Captured without pupil dilation
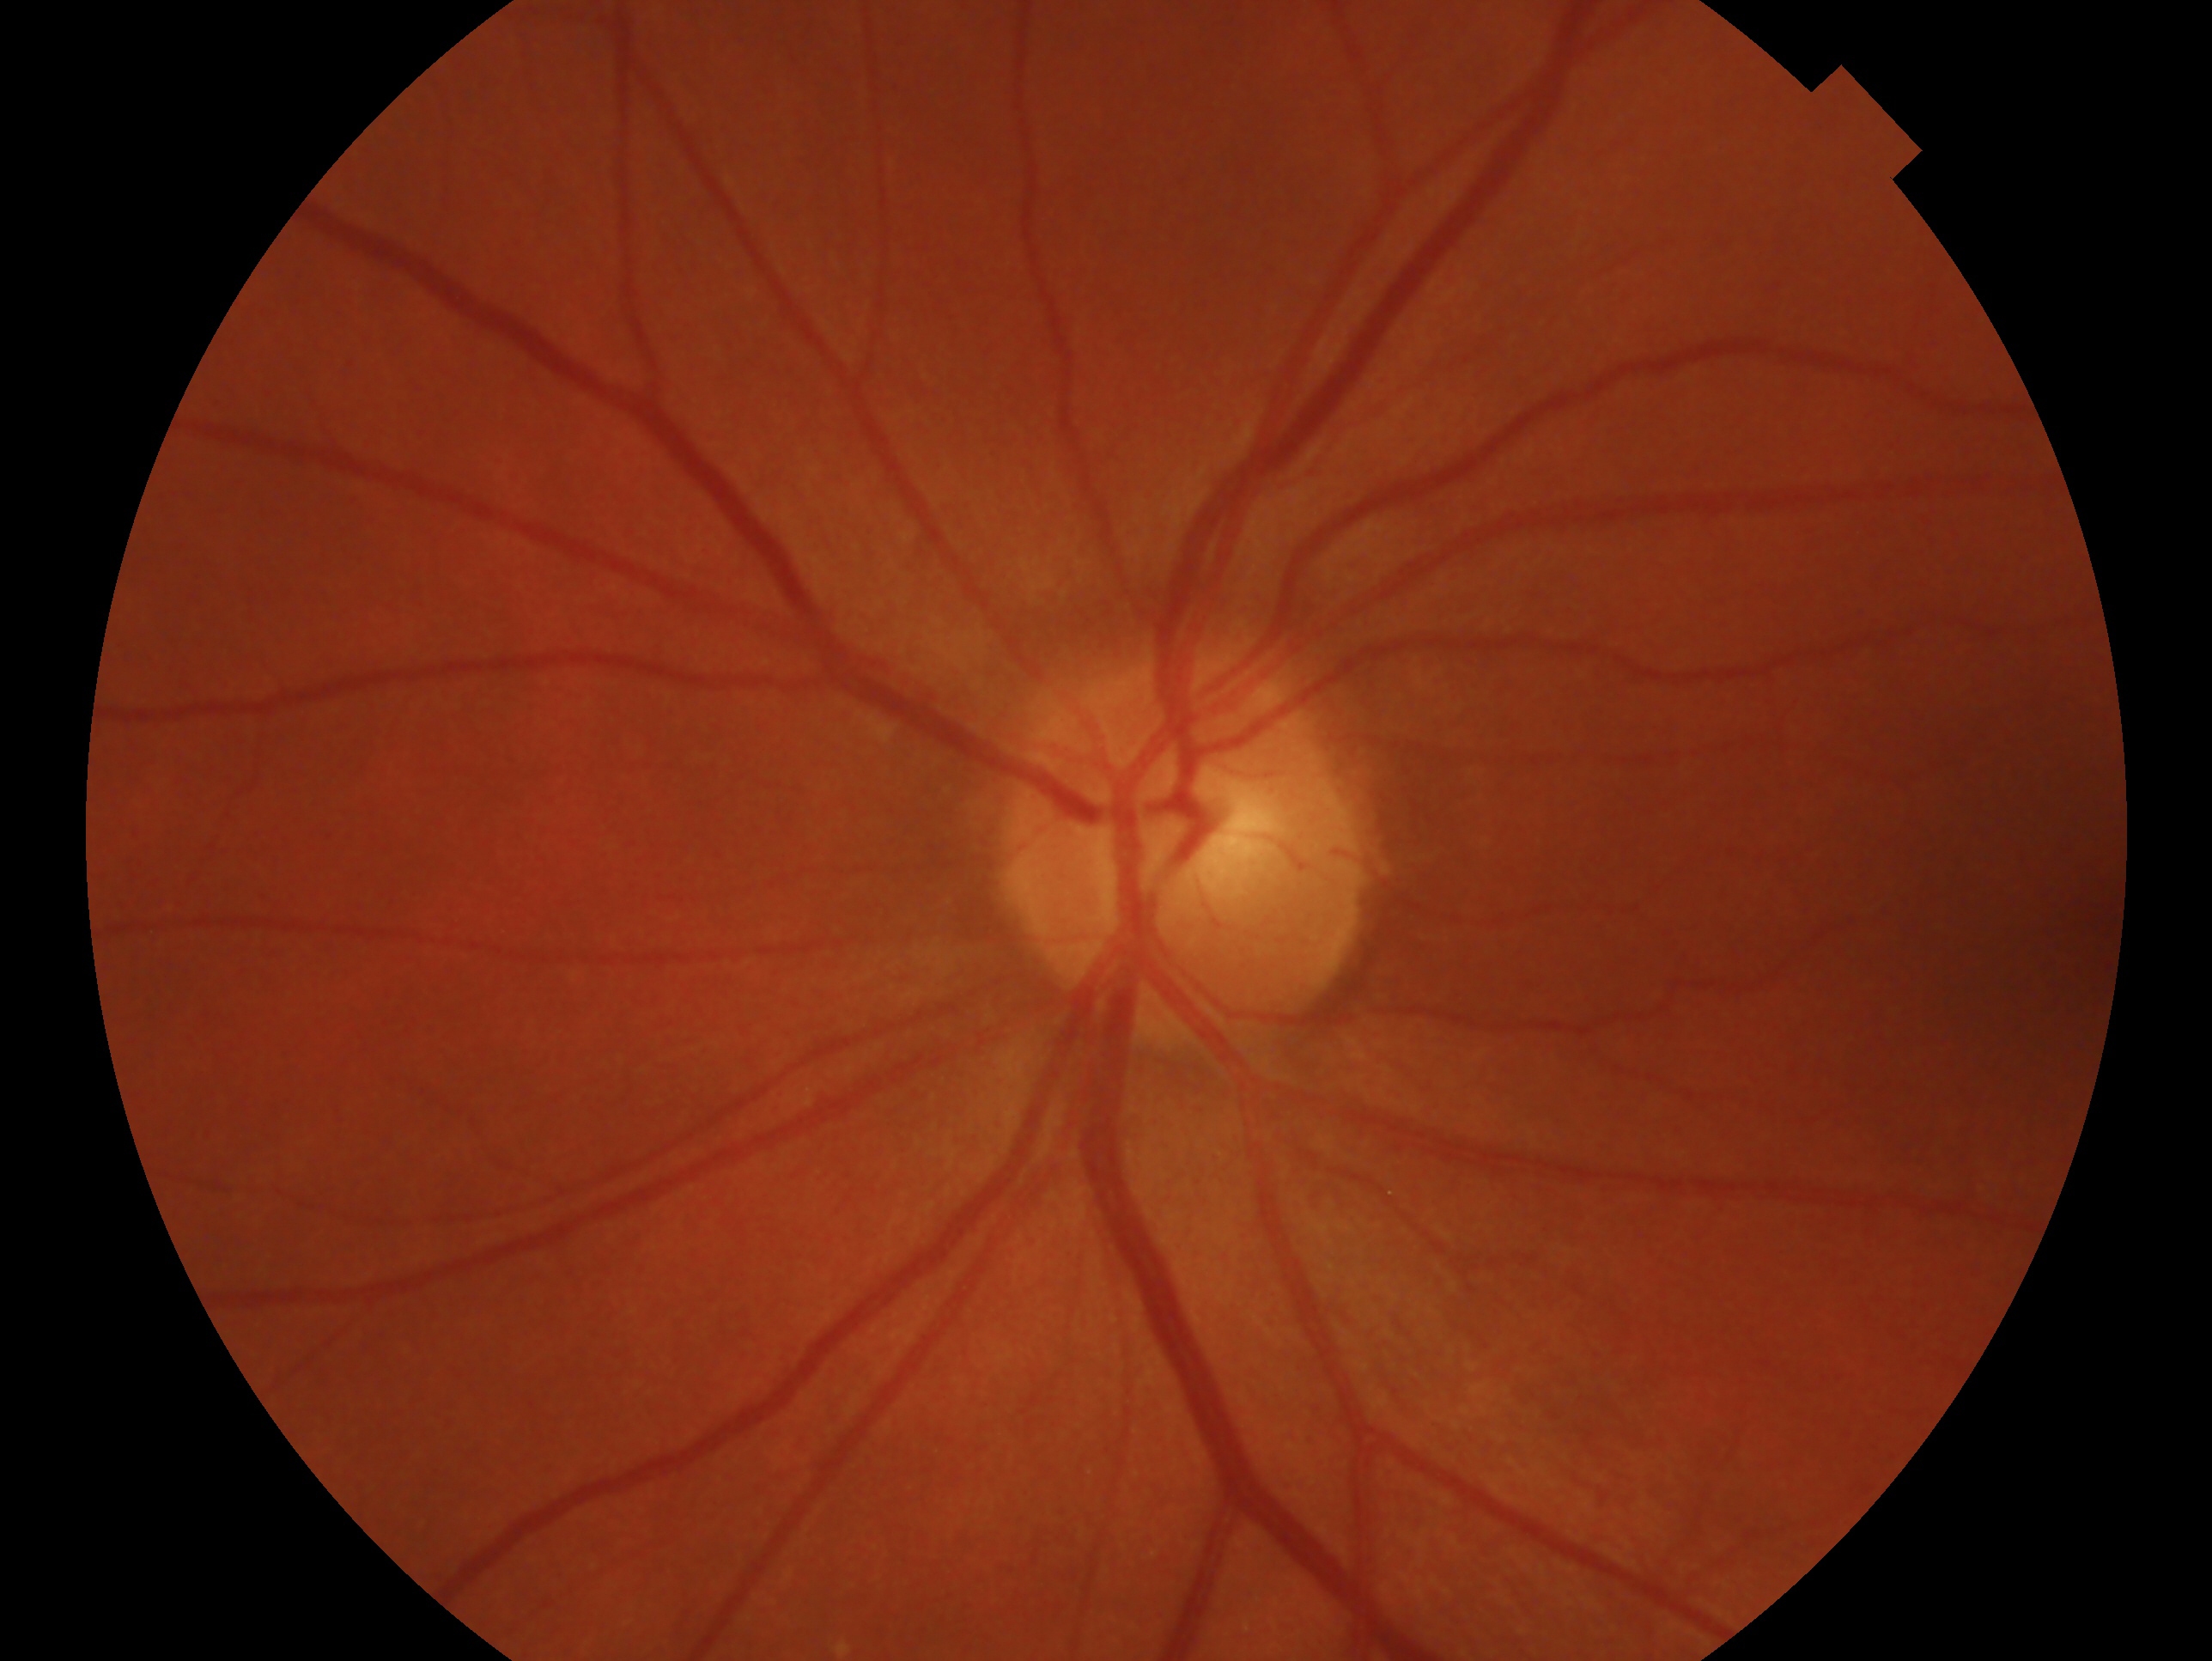
Glaucoma assessment: negative for glaucoma — no clinical evidence of glaucoma in this eye. Imaged eye: OS.